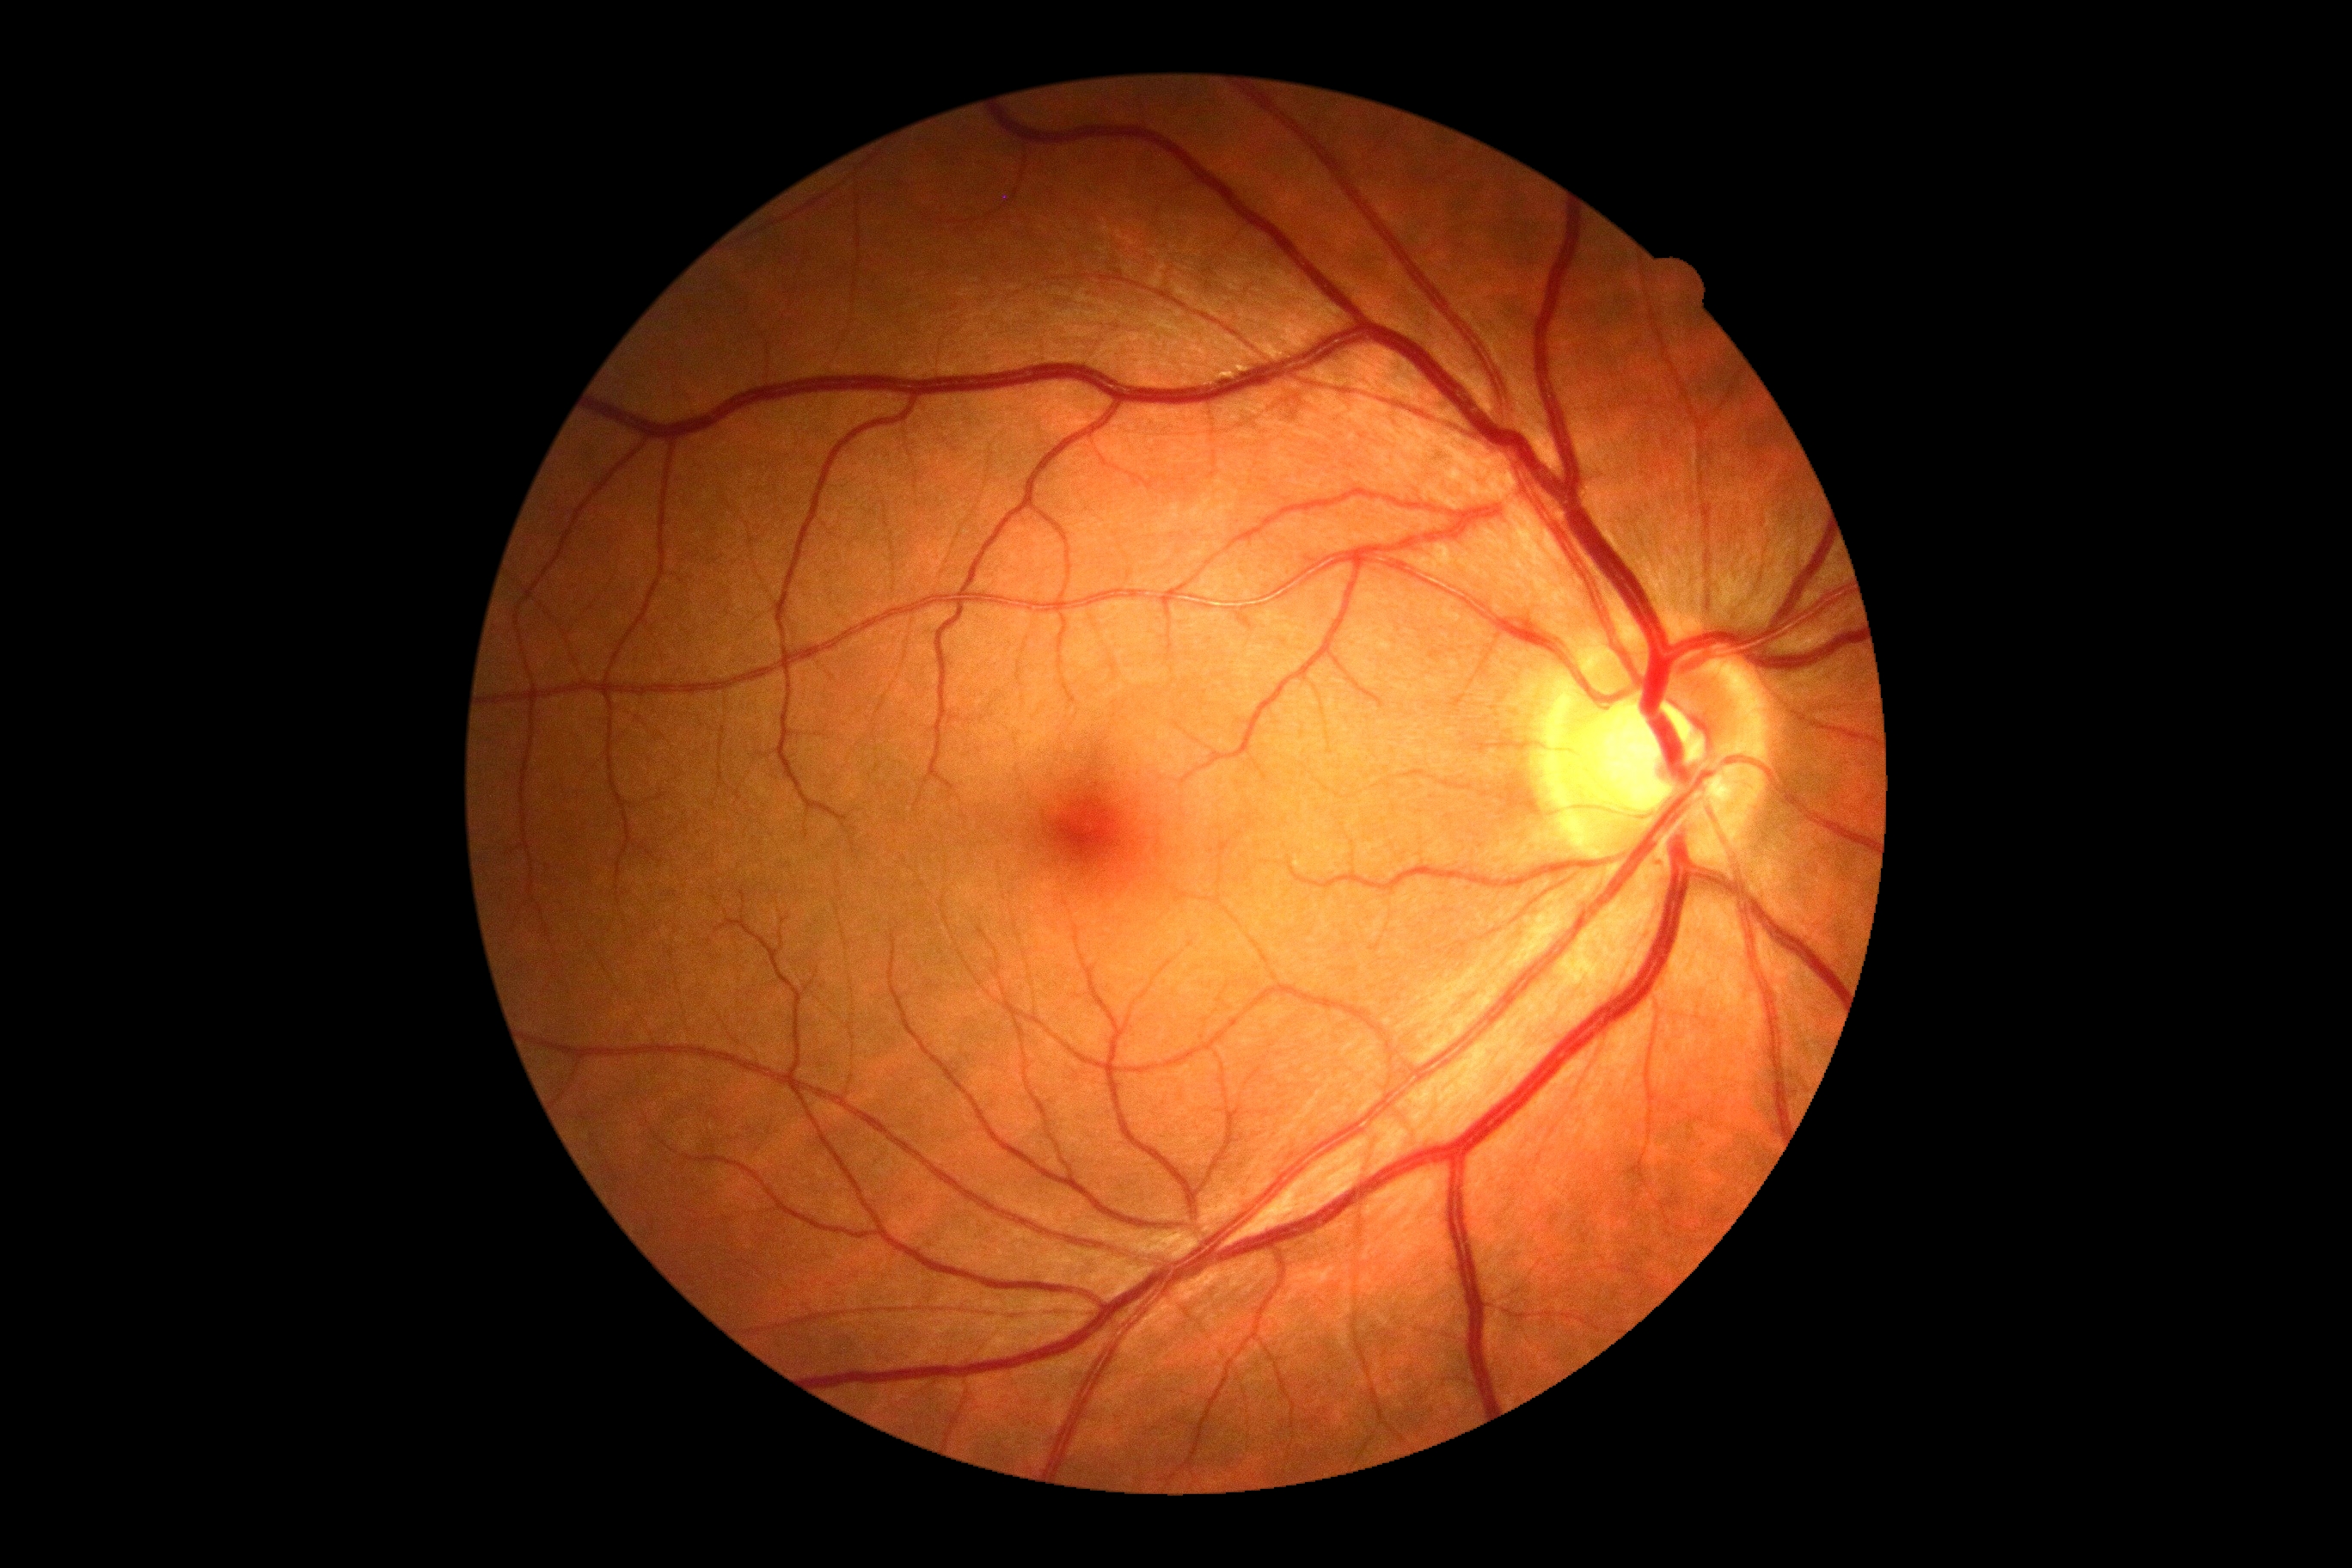
retinopathy grade = 0 (no apparent retinopathy)